Phoenix ICON wide-field infant fundus image · Phoenix ICON, 100° FOV · 1240x1240.
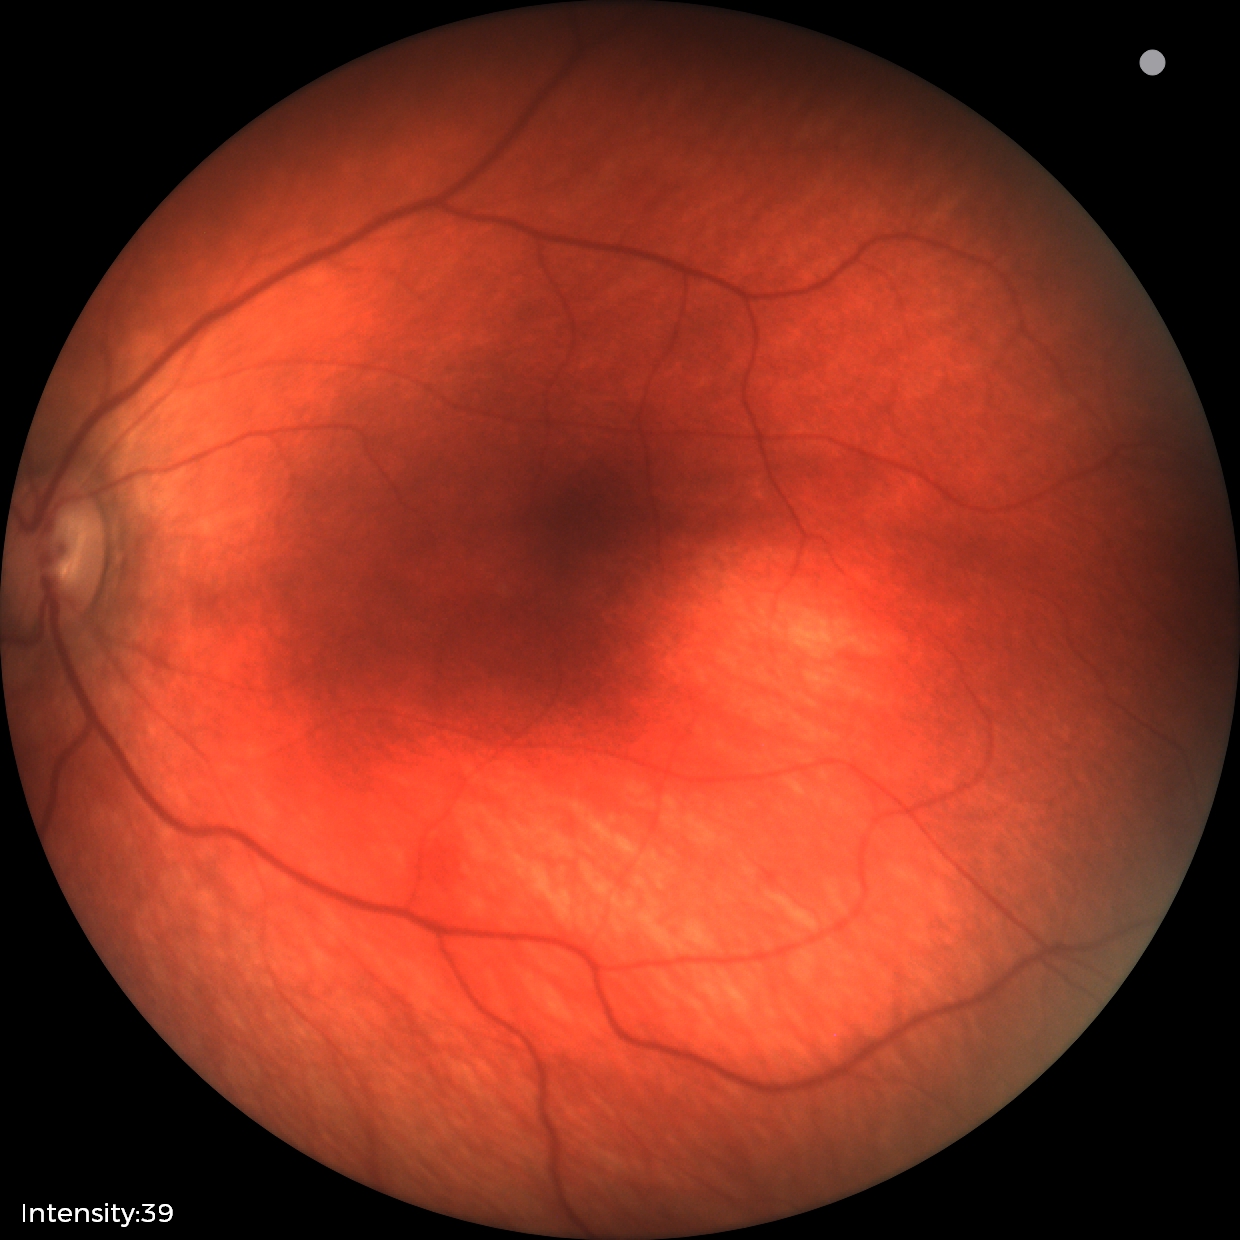
Screening diagnosis = retinal hemorrhages.